Infant wide-field retinal image. Phoenix ICON, 100° FOV:
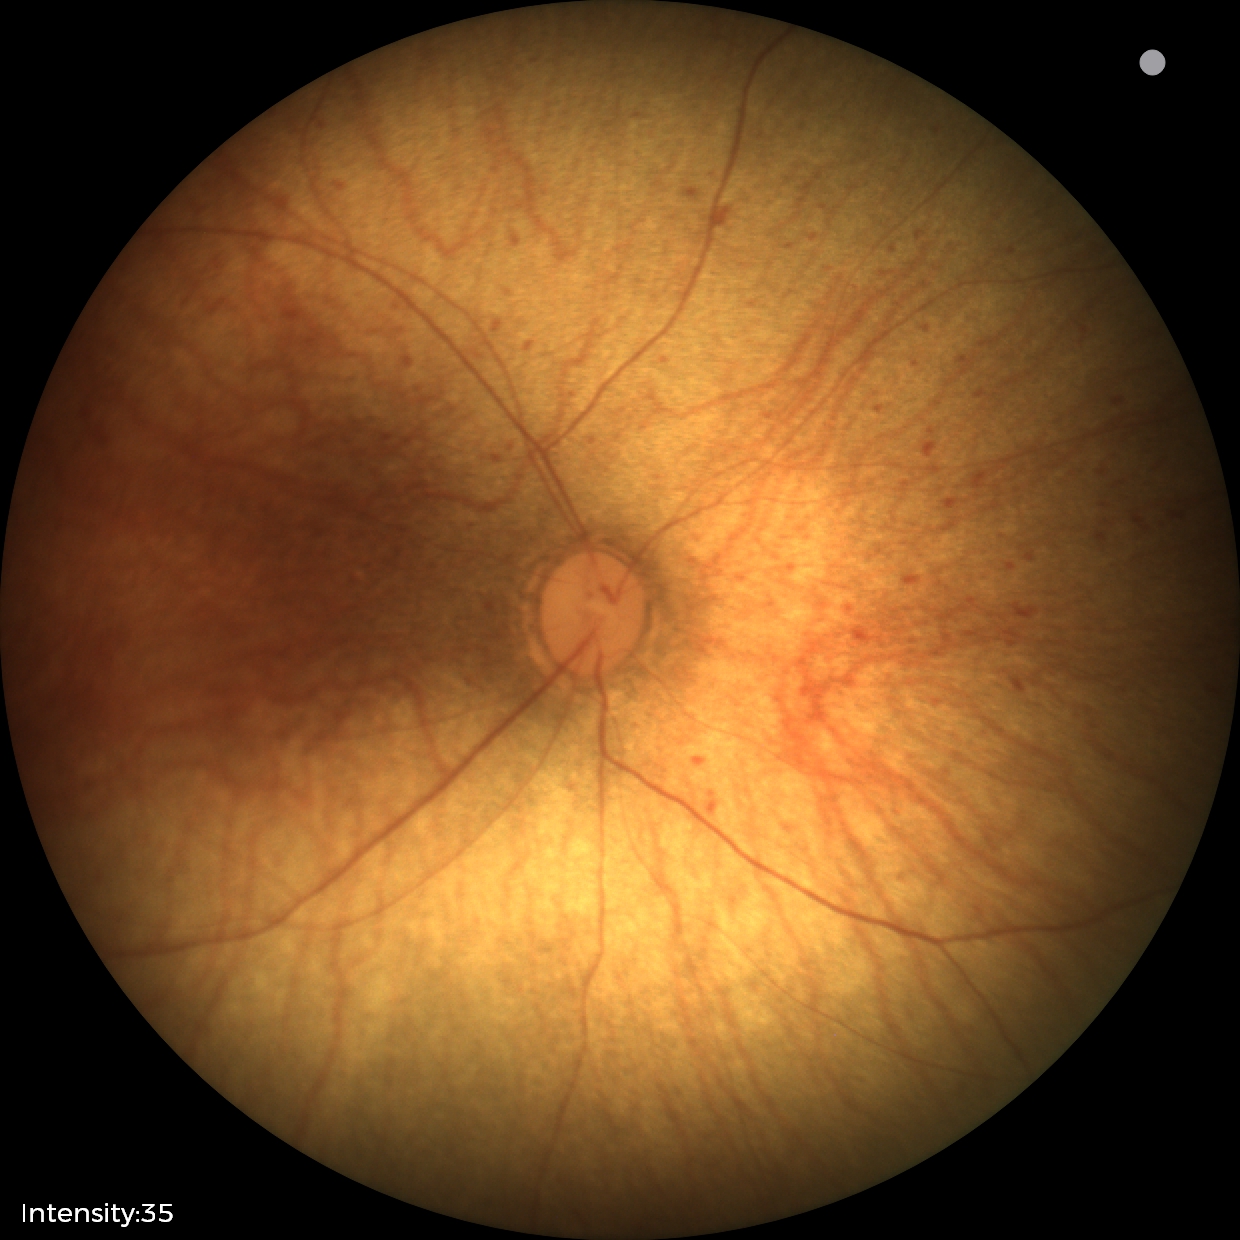

No retinal pathology identified on screening.